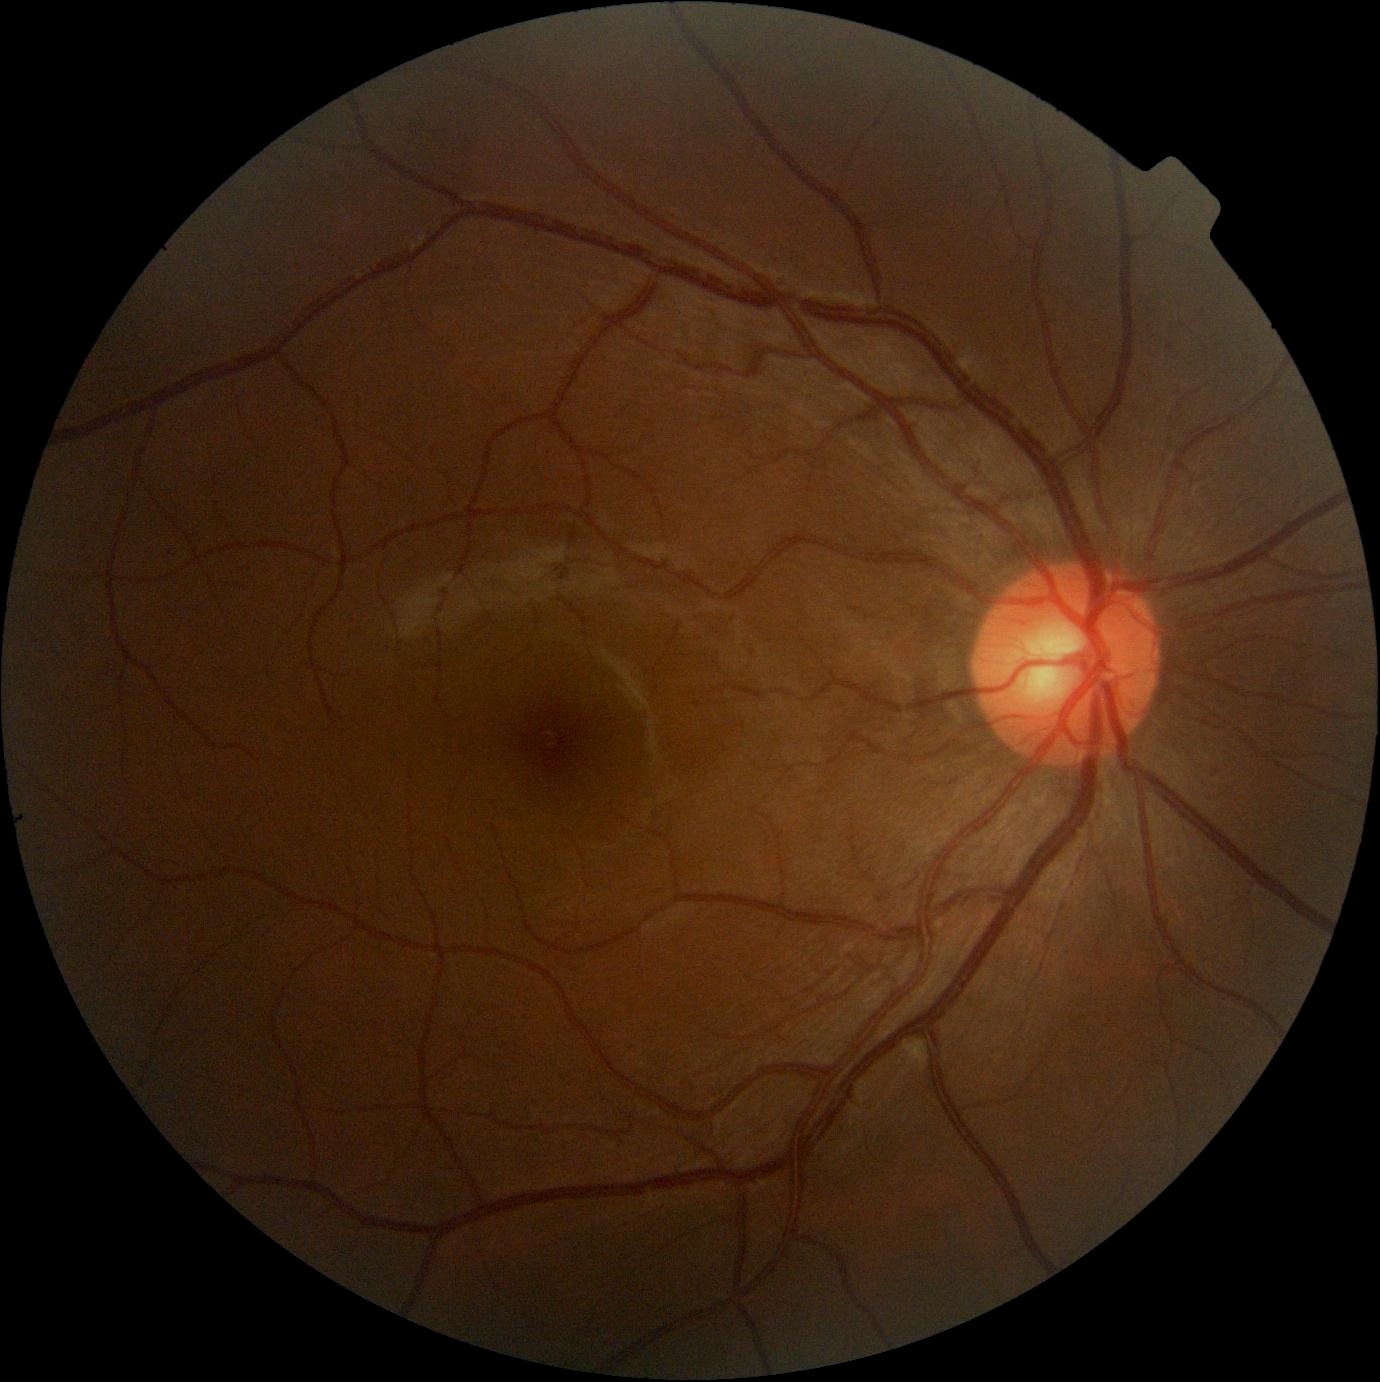 DR: grade 0 (no apparent retinopathy).